Graded on the modified Davis scale: 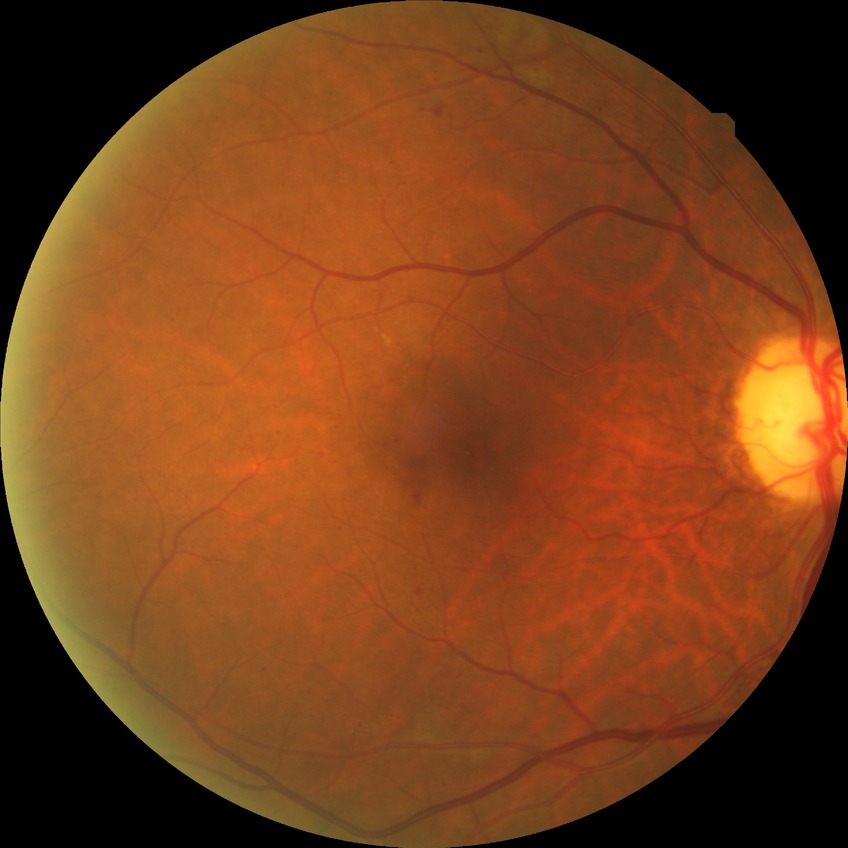 Annotations:
– diabetic retinopathy (DR): SDR (simple diabetic retinopathy)